Nonmydriatic.
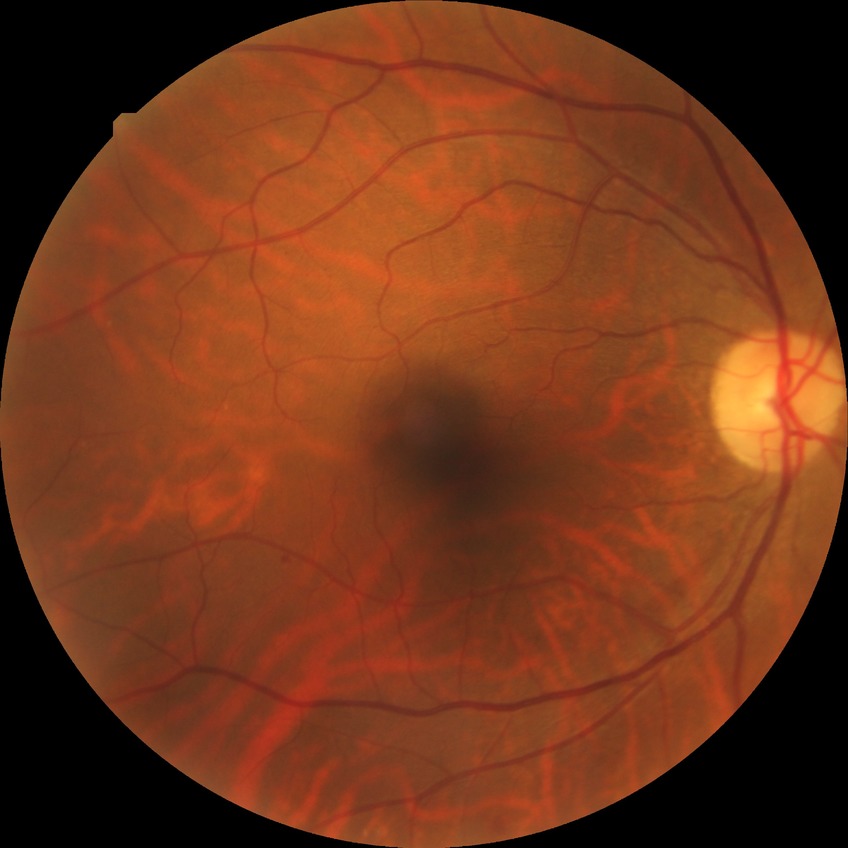 {
  "davis_grade": "simple diabetic retinopathy (SDR)"
}